Color fundus image · nonmydriatic fundus photograph:
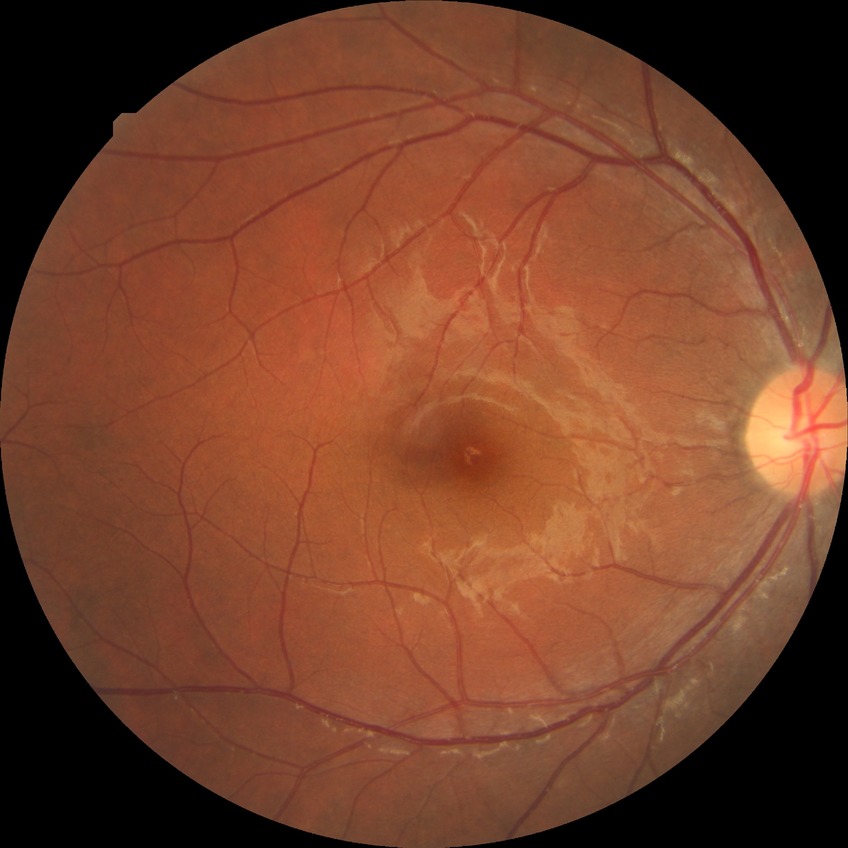

Modified Davis grading: no diabetic retinopathy.